2352x1568px; 45° FOV.
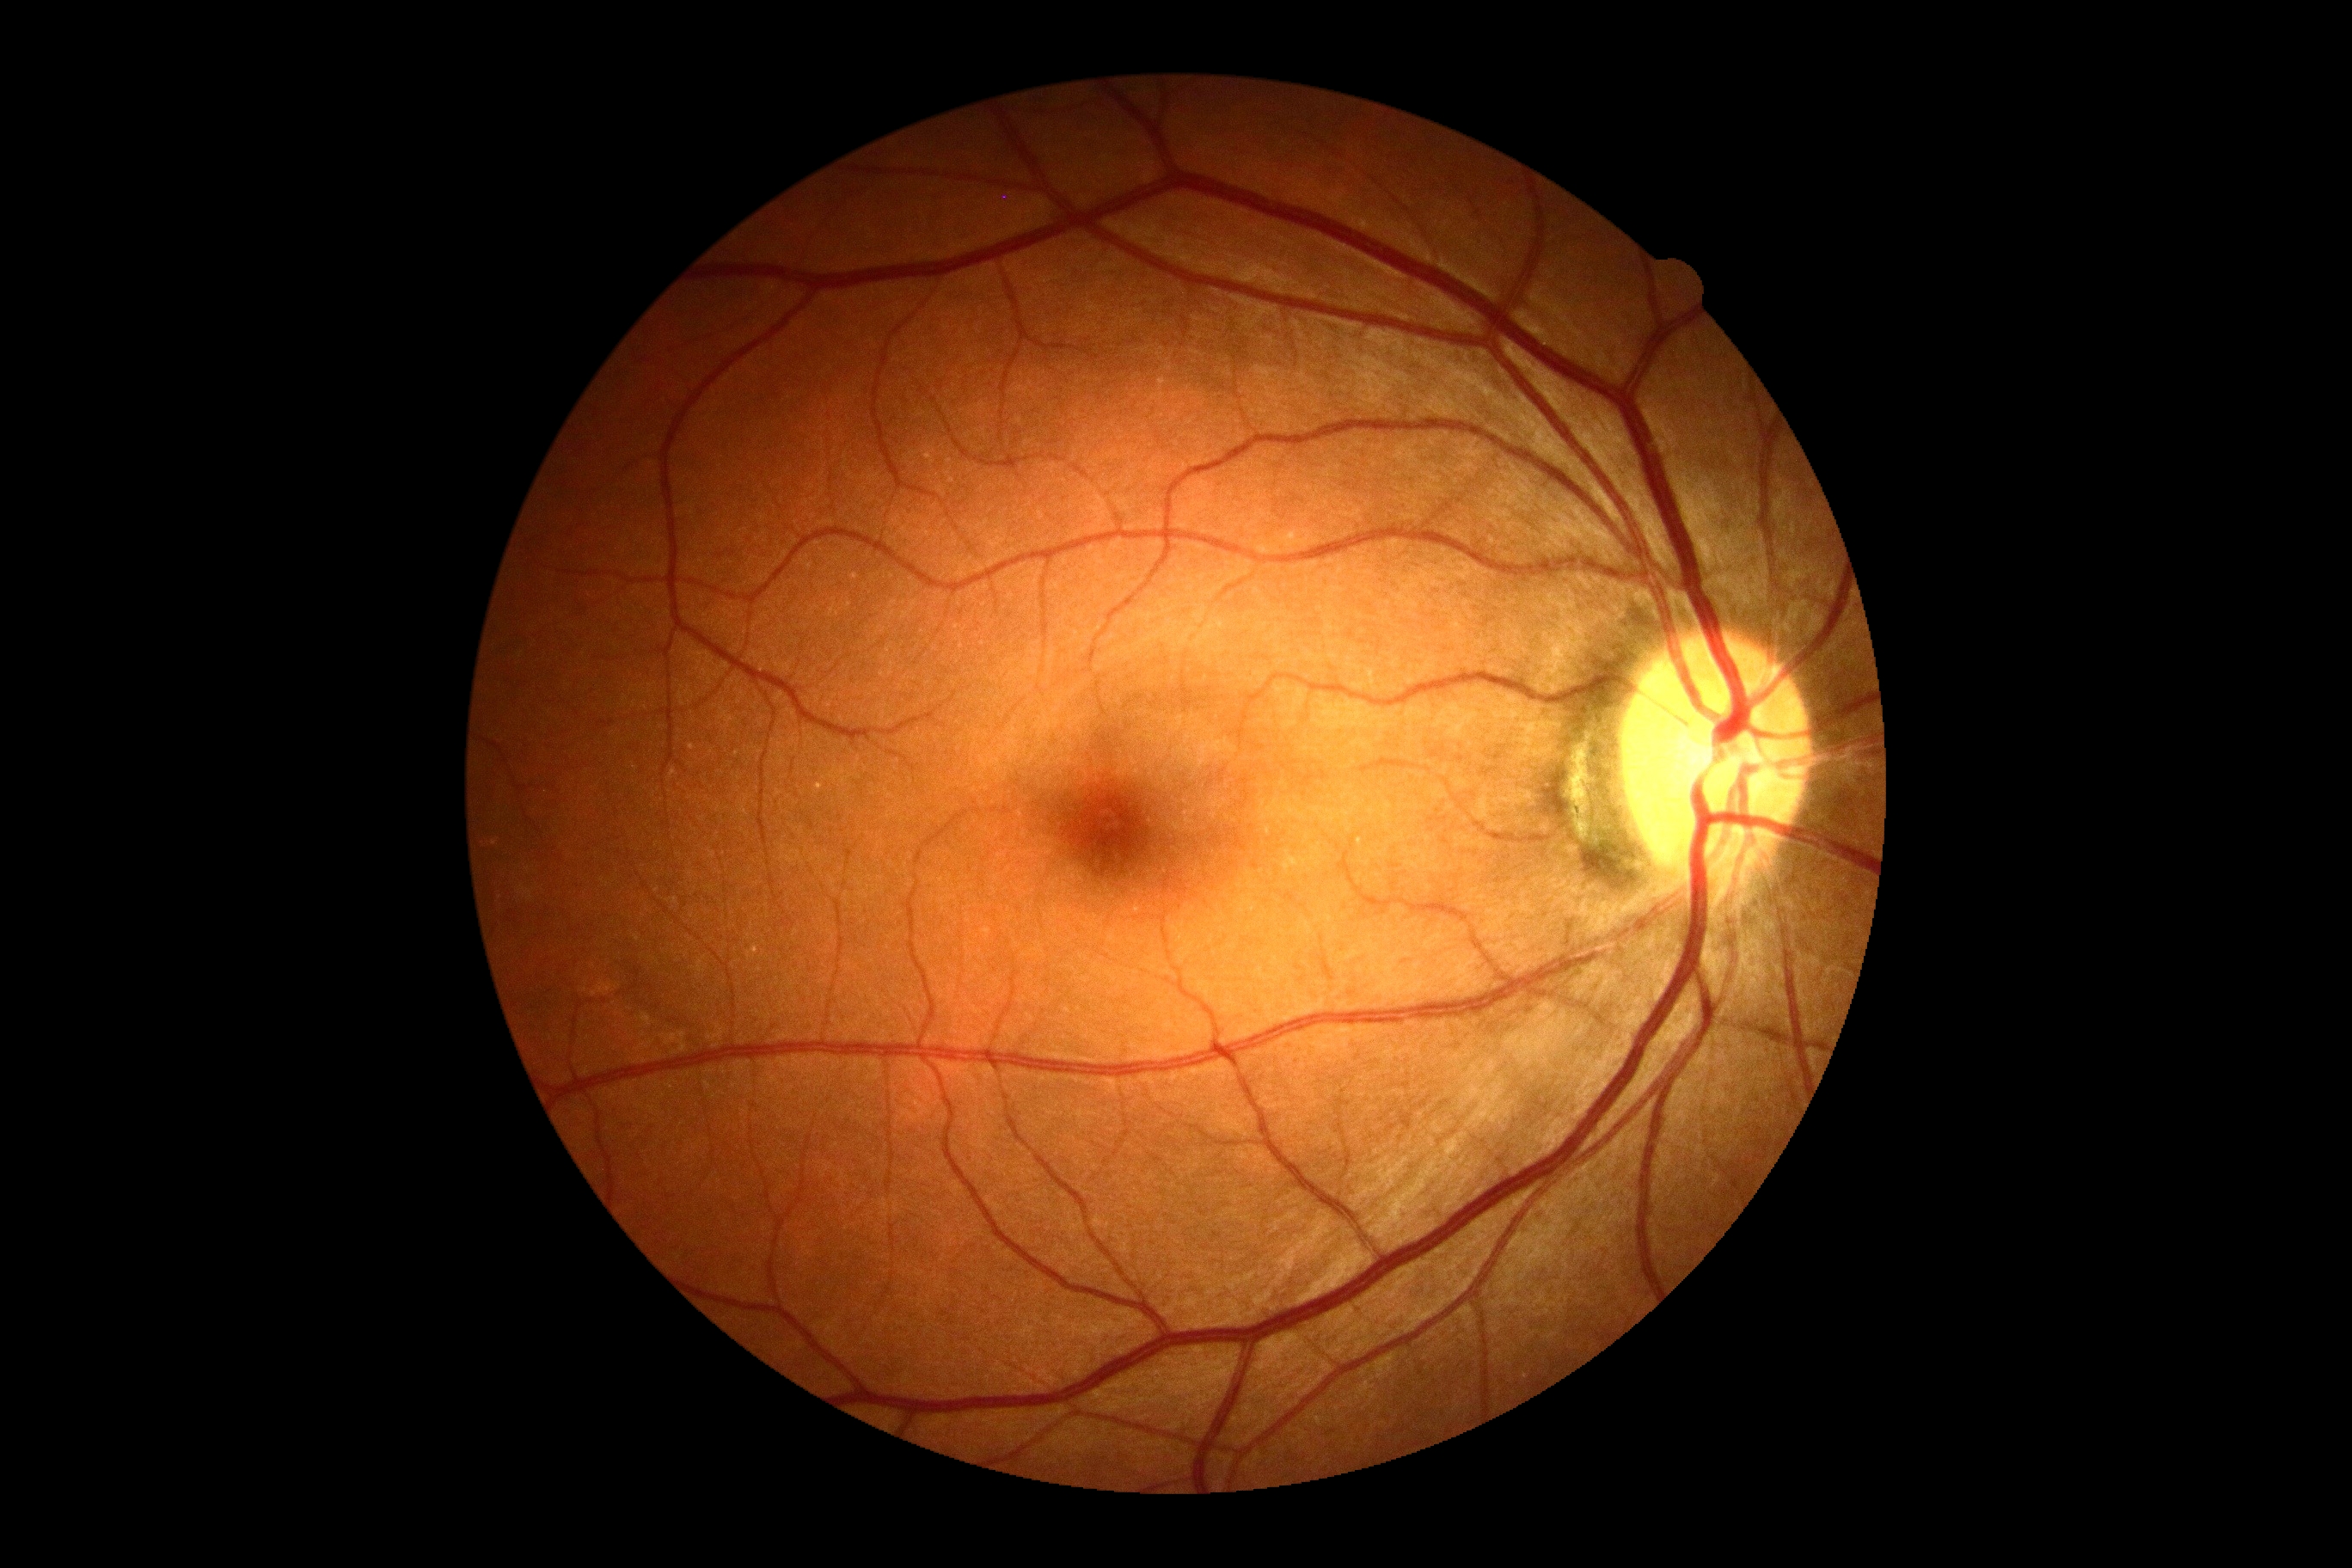

Diabetic retinopathy severity is 0.